Camera: NIDEK AFC-230, nonmydriatic, 848x848 — 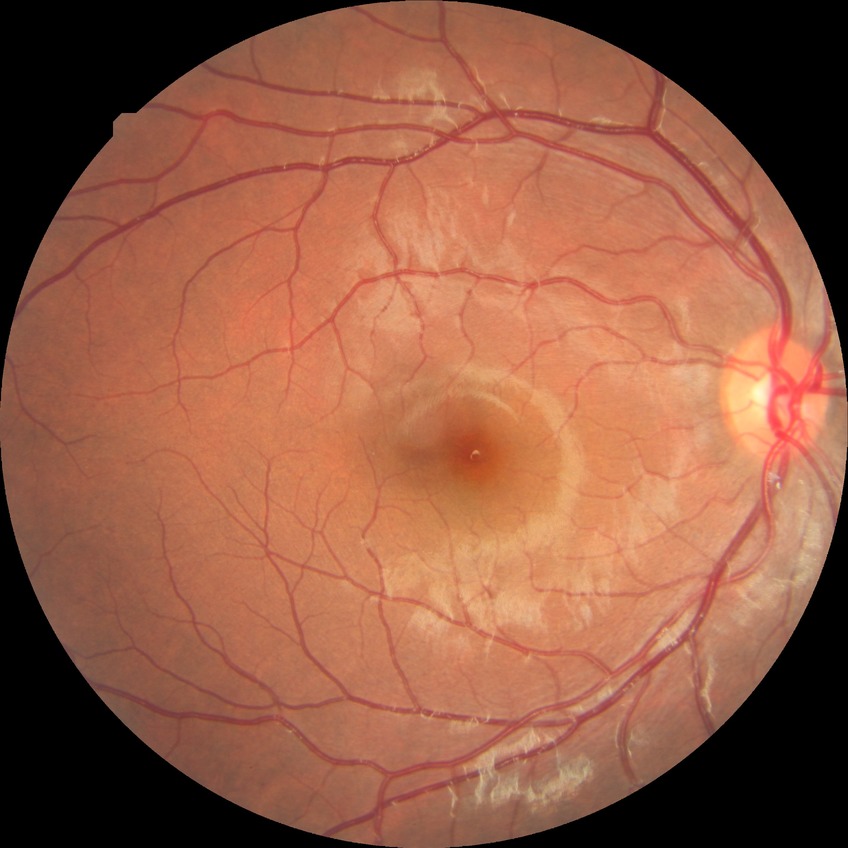 {"davis_grade": "NDR (no diabetic retinopathy)"}